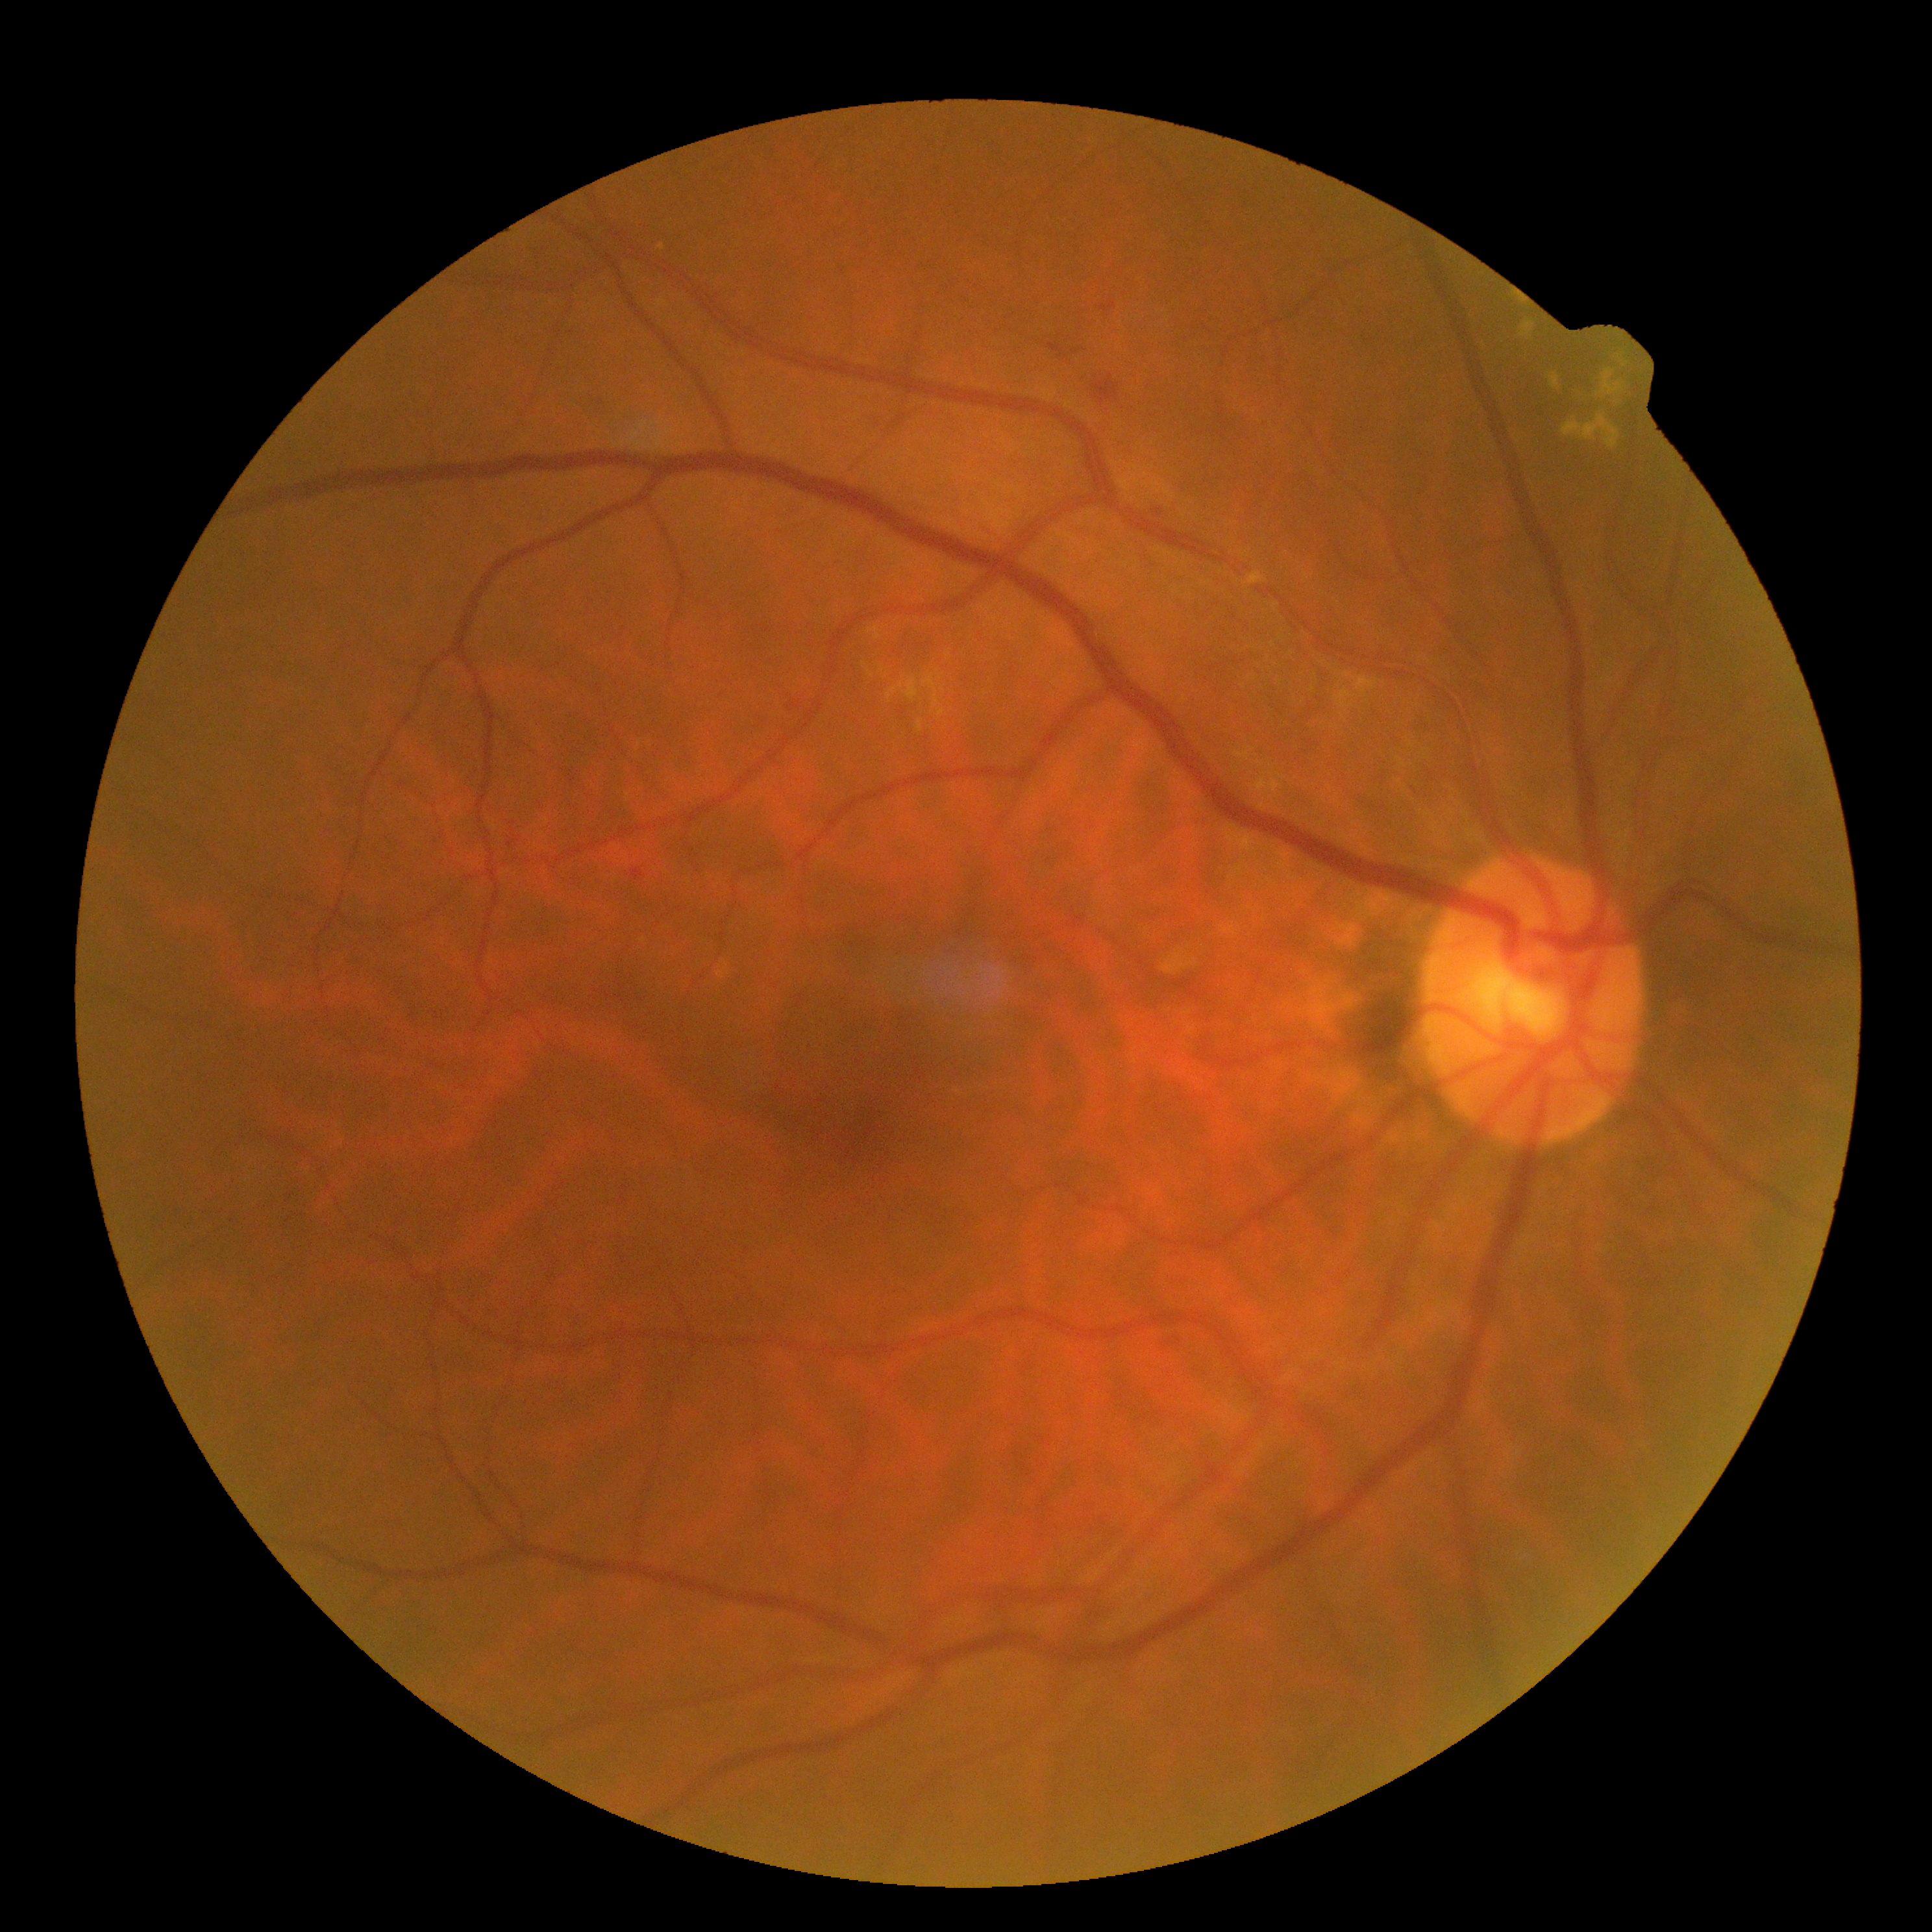
retinopathy grade = moderate NPDR (2), DR class = non-proliferative diabetic retinopathy.